RetCam wide-field infant fundus image; 130° field of view (Clarity RetCam 3); 640x480:
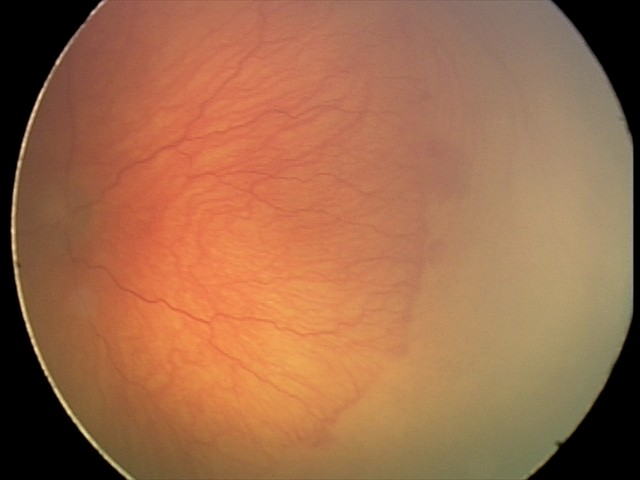
Plus disease = present
assessment = aggressive retinopathy of prematurity